FOV: 45 degrees.
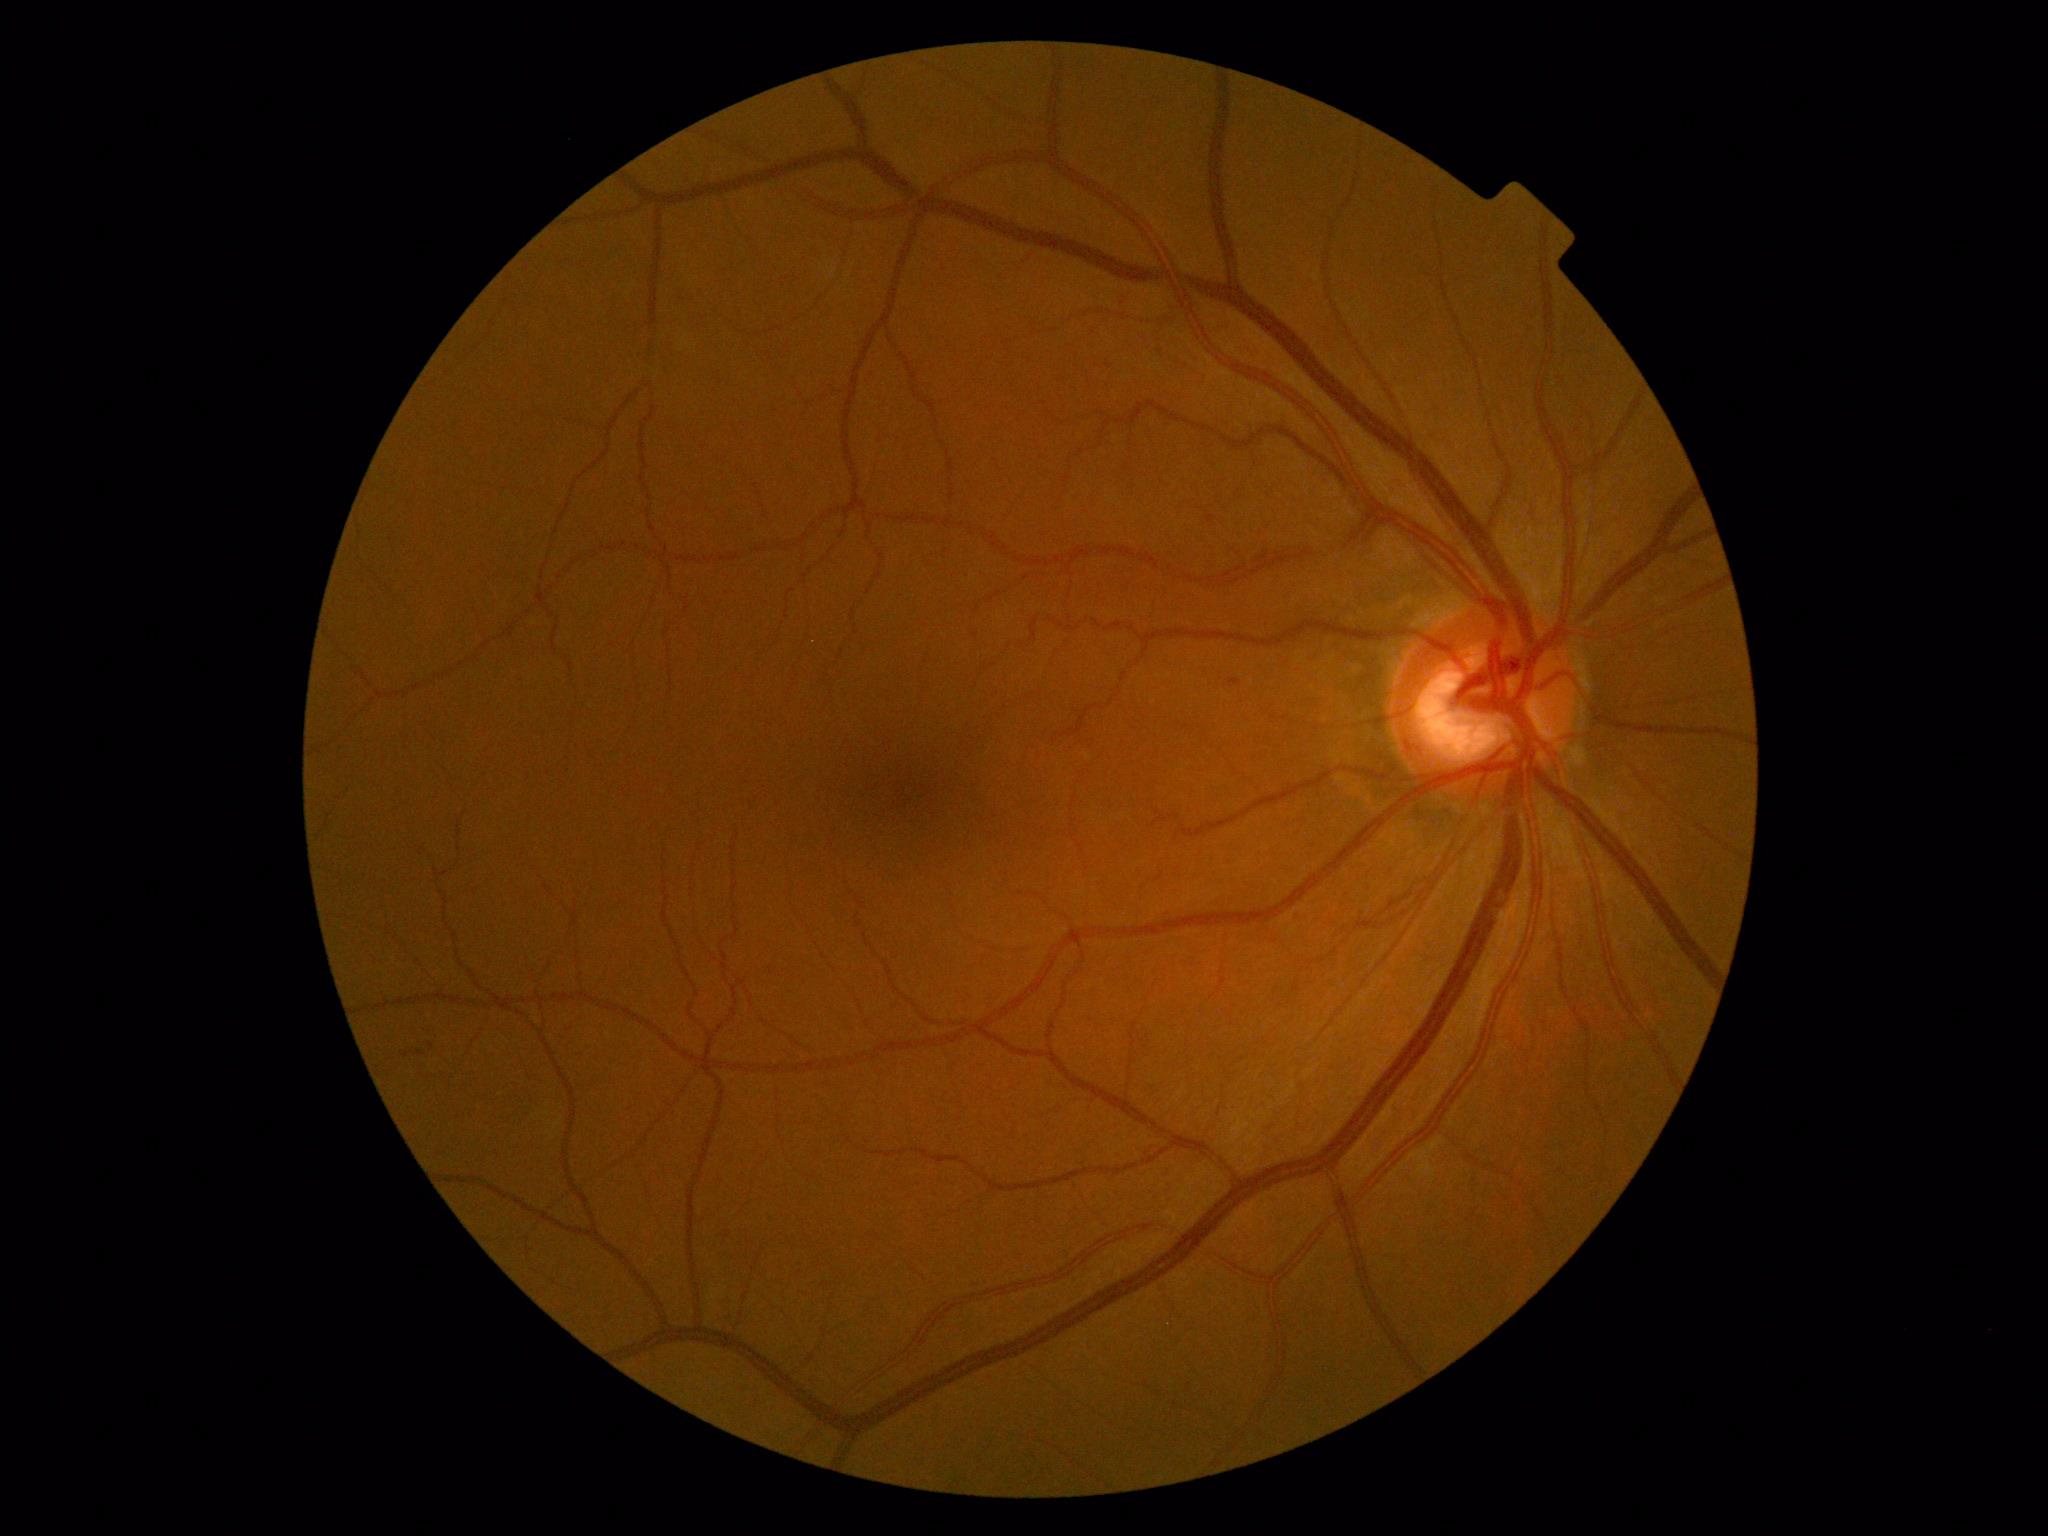 DR grade = mild NPDR (1) | DR class = non-proliferative diabetic retinopathy.